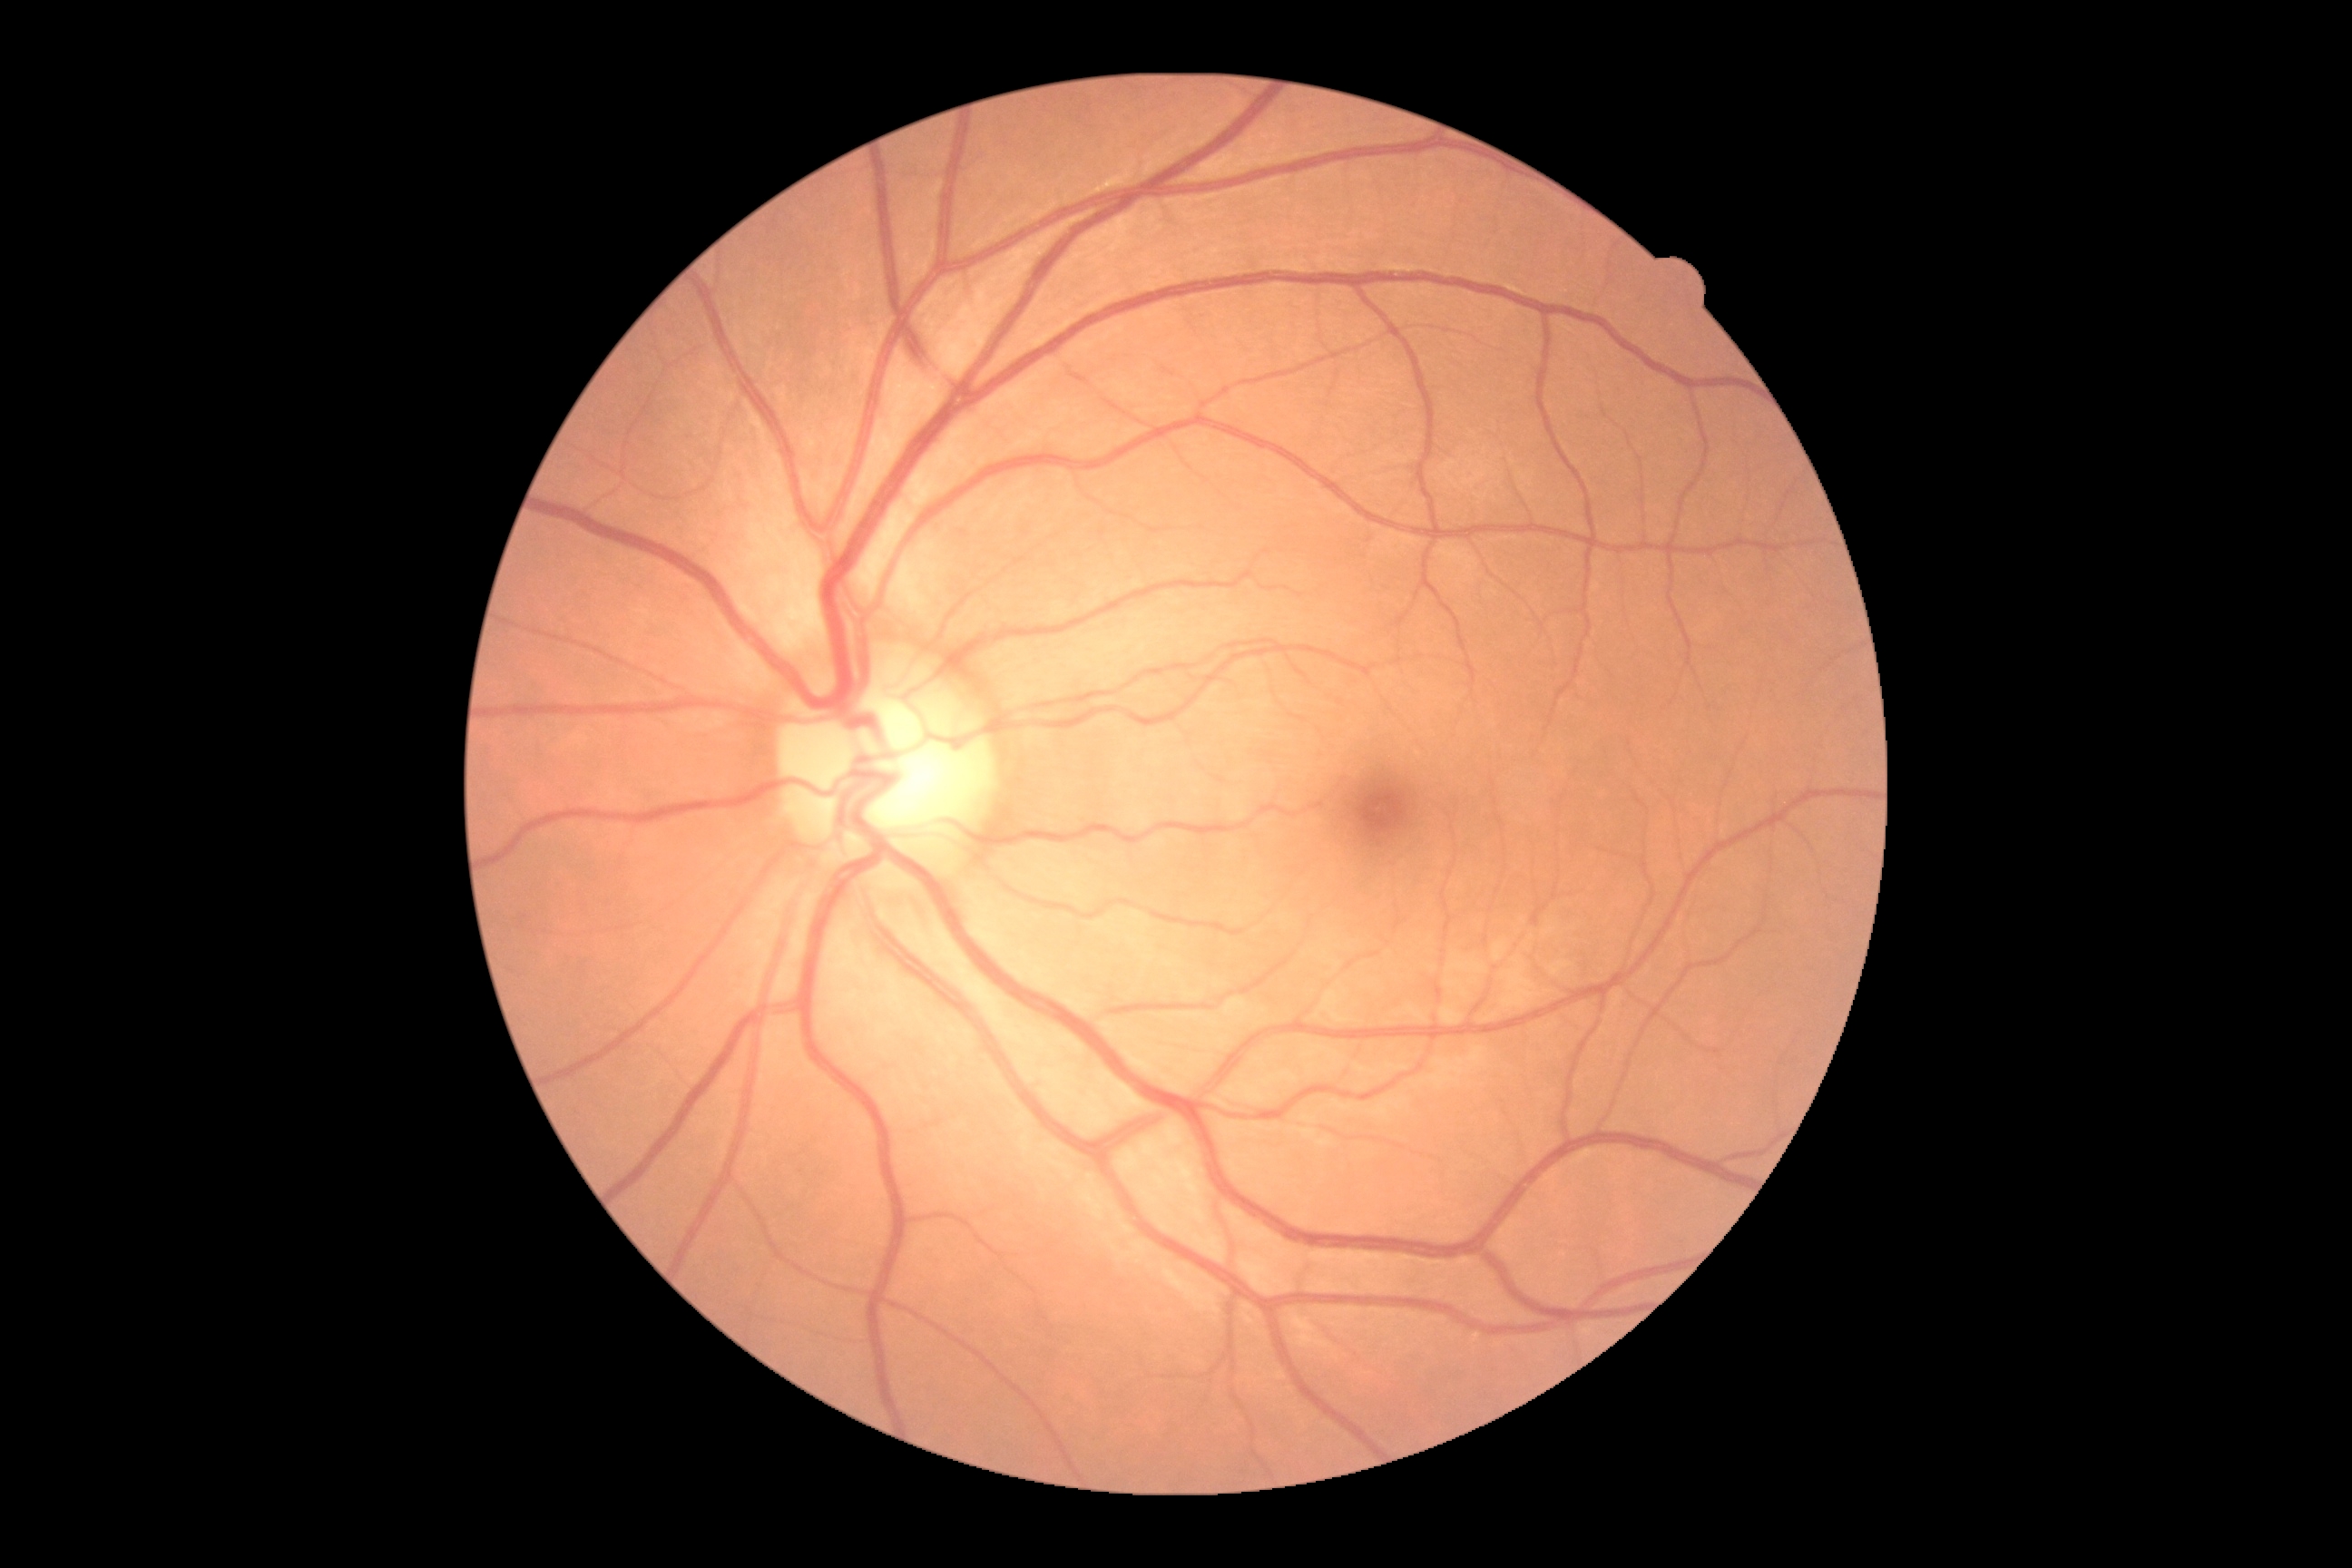

Diabetic retinopathy (DR): no apparent diabetic retinopathy (grade 0).